Posterior pole color fundus photograph.
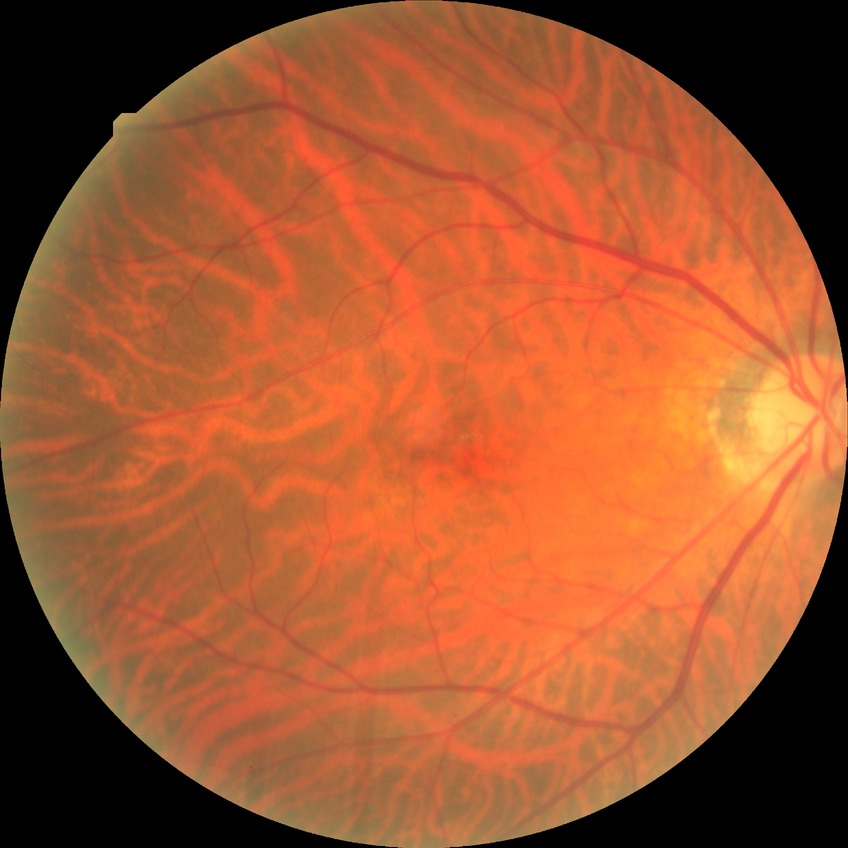

Diabetic retinopathy (DR) is no diabetic retinopathy (NDR).